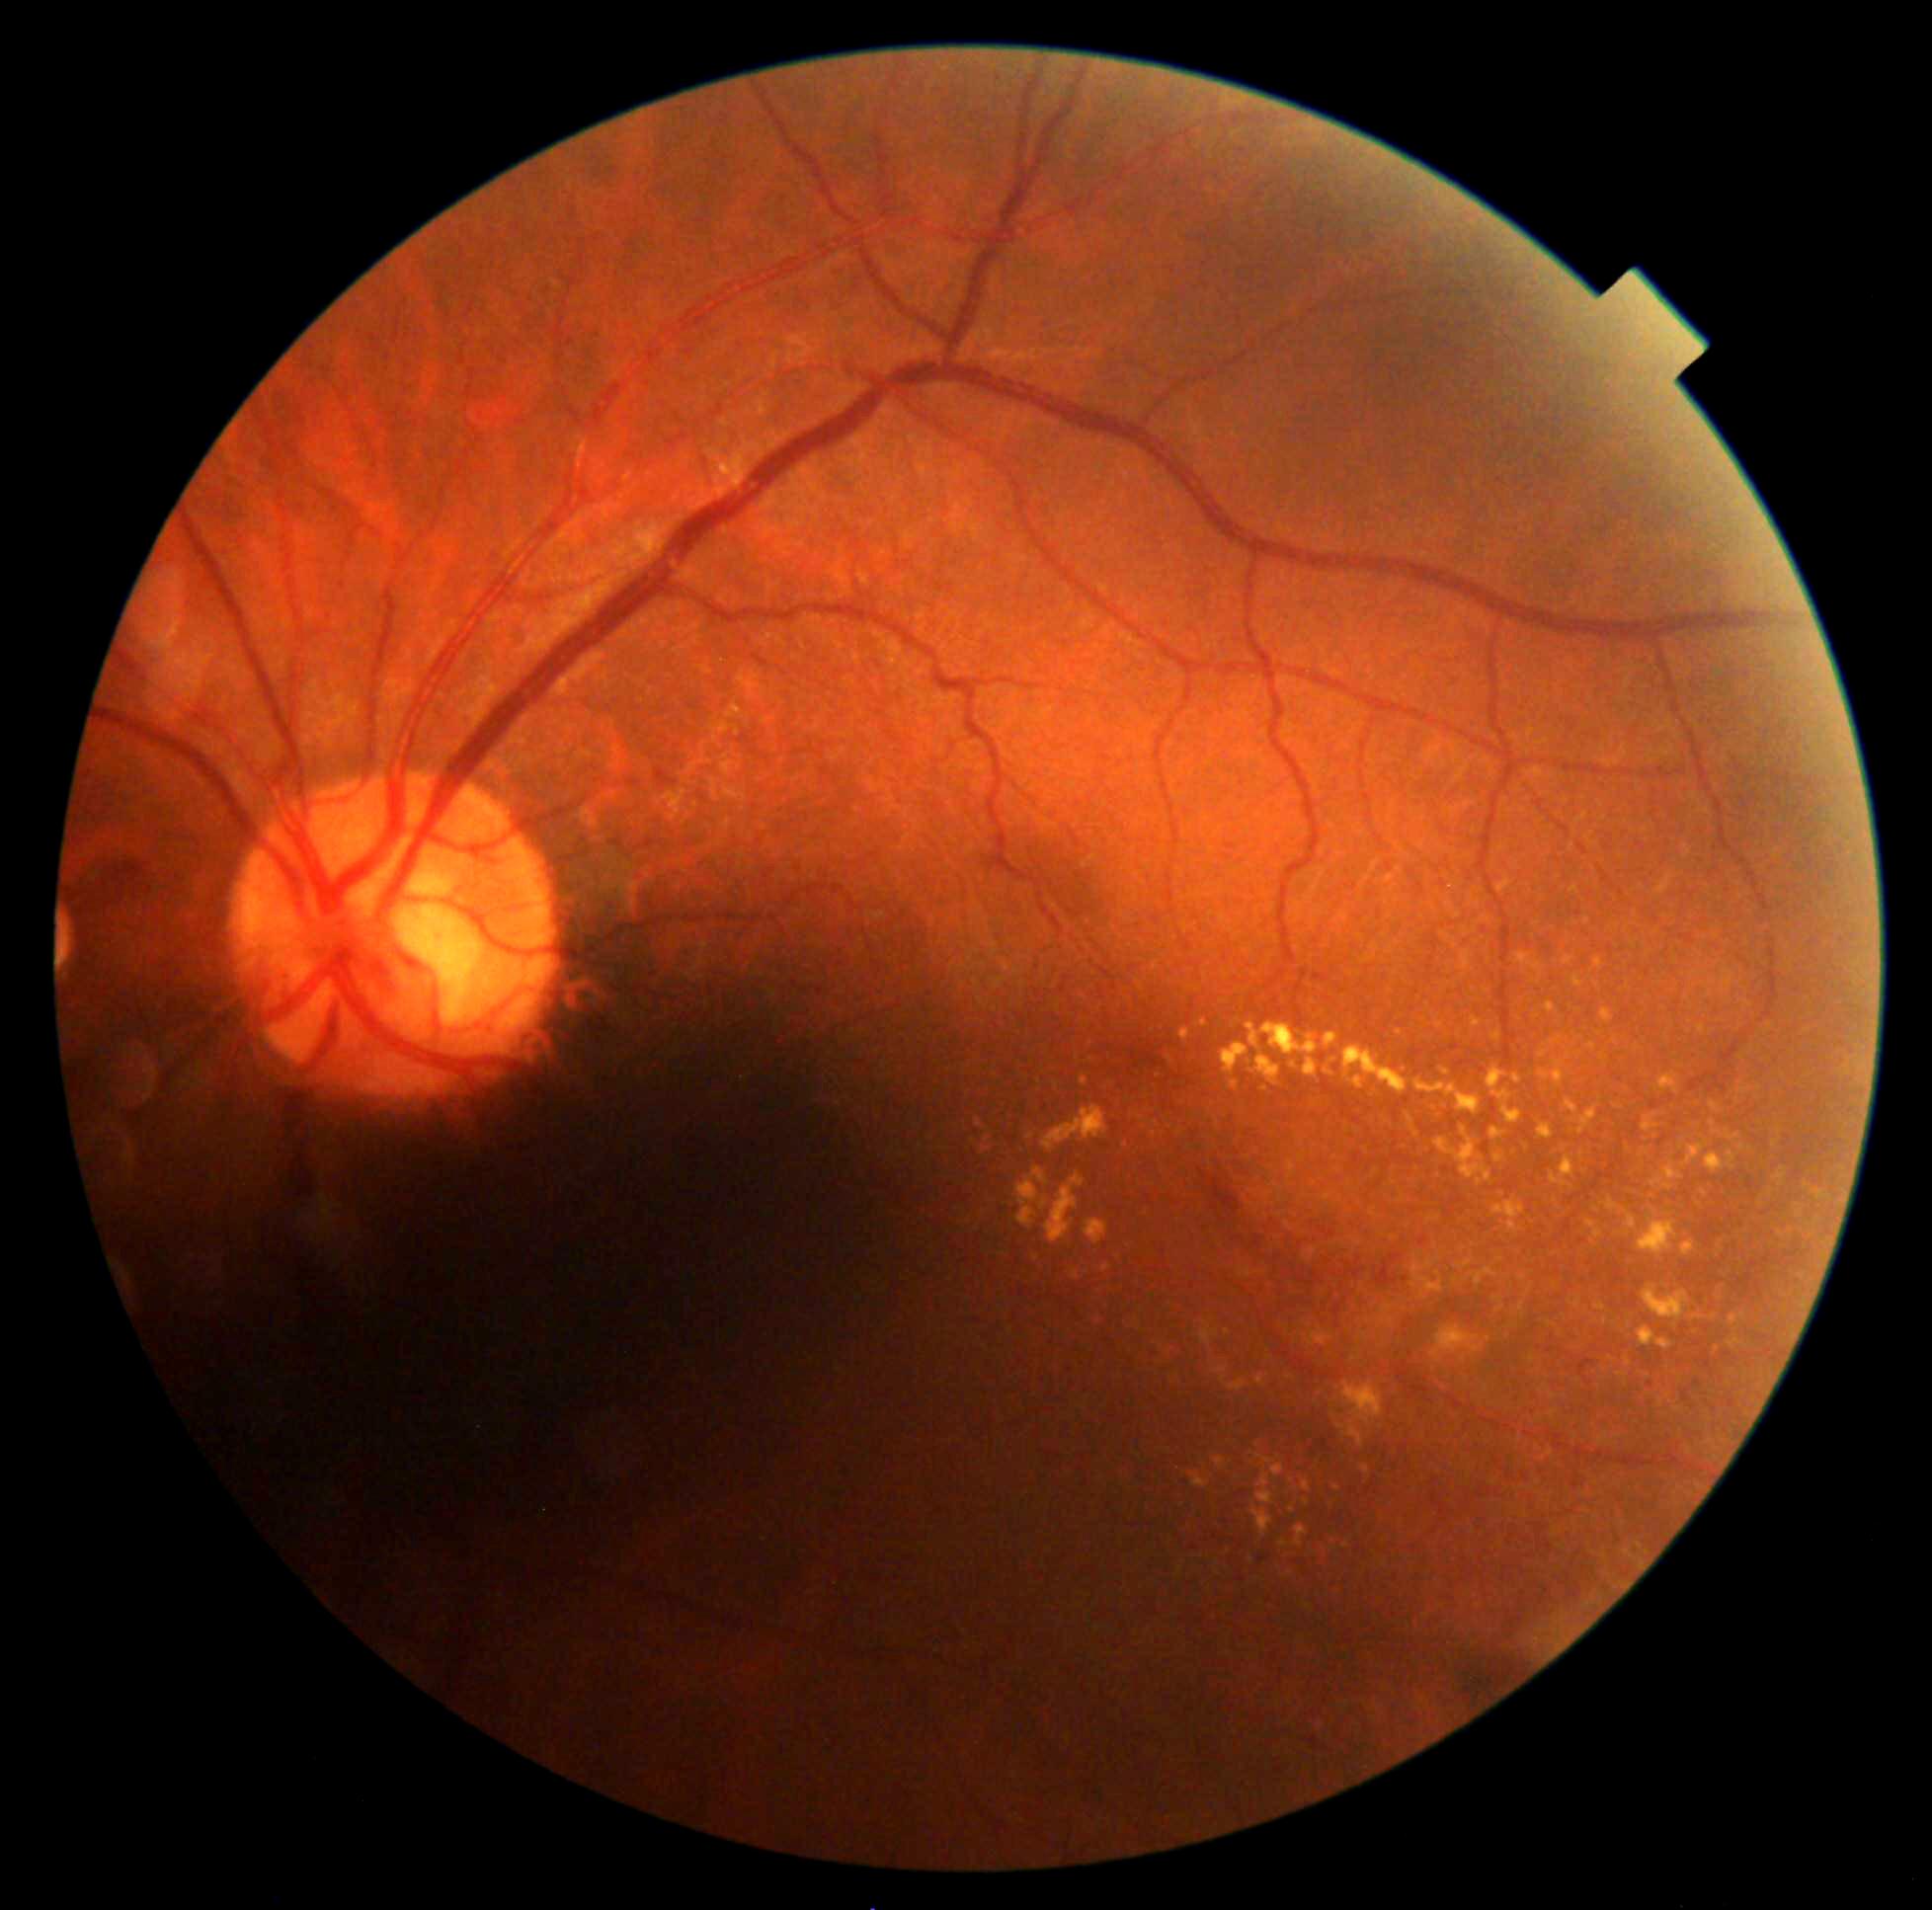

Diabetic retinopathy (DR) is moderate NPDR (grade 2)
Lesions identified (partial list):
hard exudates (EXs) (more not shown): [1549,1037,1562,1046], [1692,1314,1703,1321], [1551,1156,1575,1191], [1040,1198,1049,1213], [1016,1167,1049,1231], [1198,1020,1209,1028], [1325,1033,1339,1051], [1588,1044,1597,1051], [1711,1121,1740,1143], [1271,1465,1286,1477], [1656,874,1676,896]
Small EXs approximately at (x=1346, y=1547), (x=1597, y=1210), (x=1434, y=1108), (x=1803, y=1277), (x=1568, y=1056), (x=1250, y=1063), (x=1742, y=1059)